NIDEK AFC-230 fundus camera · 45° FOV · posterior pole color fundus photograph · 848 by 848 pixels
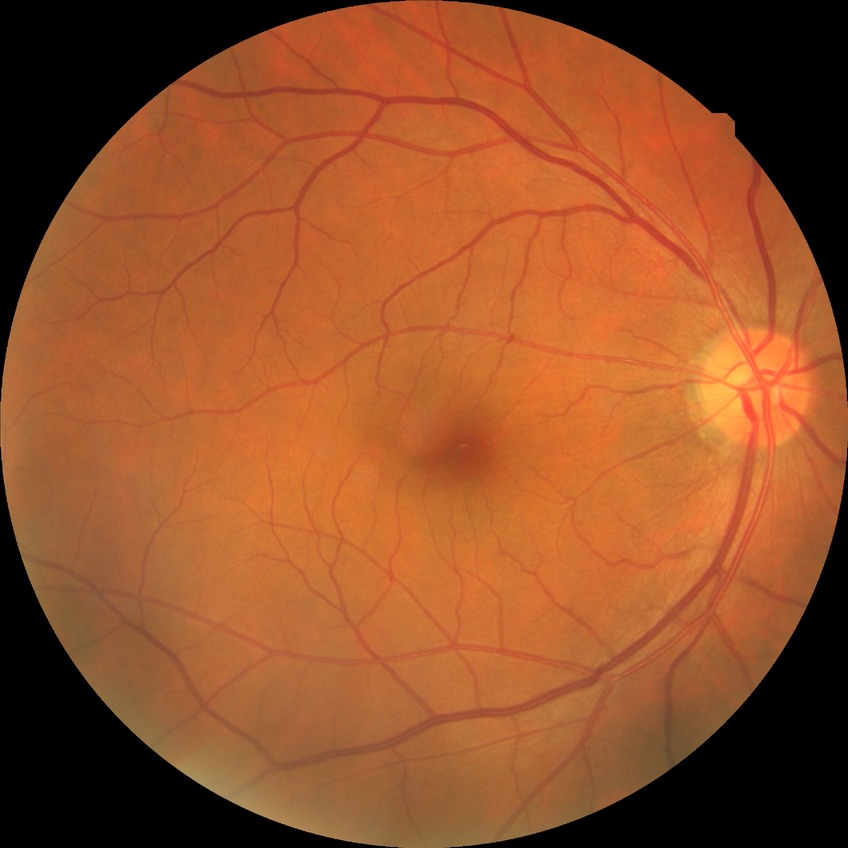 diabetic retinopathy (DR) = no diabetic retinopathy (NDR).